Retinal fundus photograph.
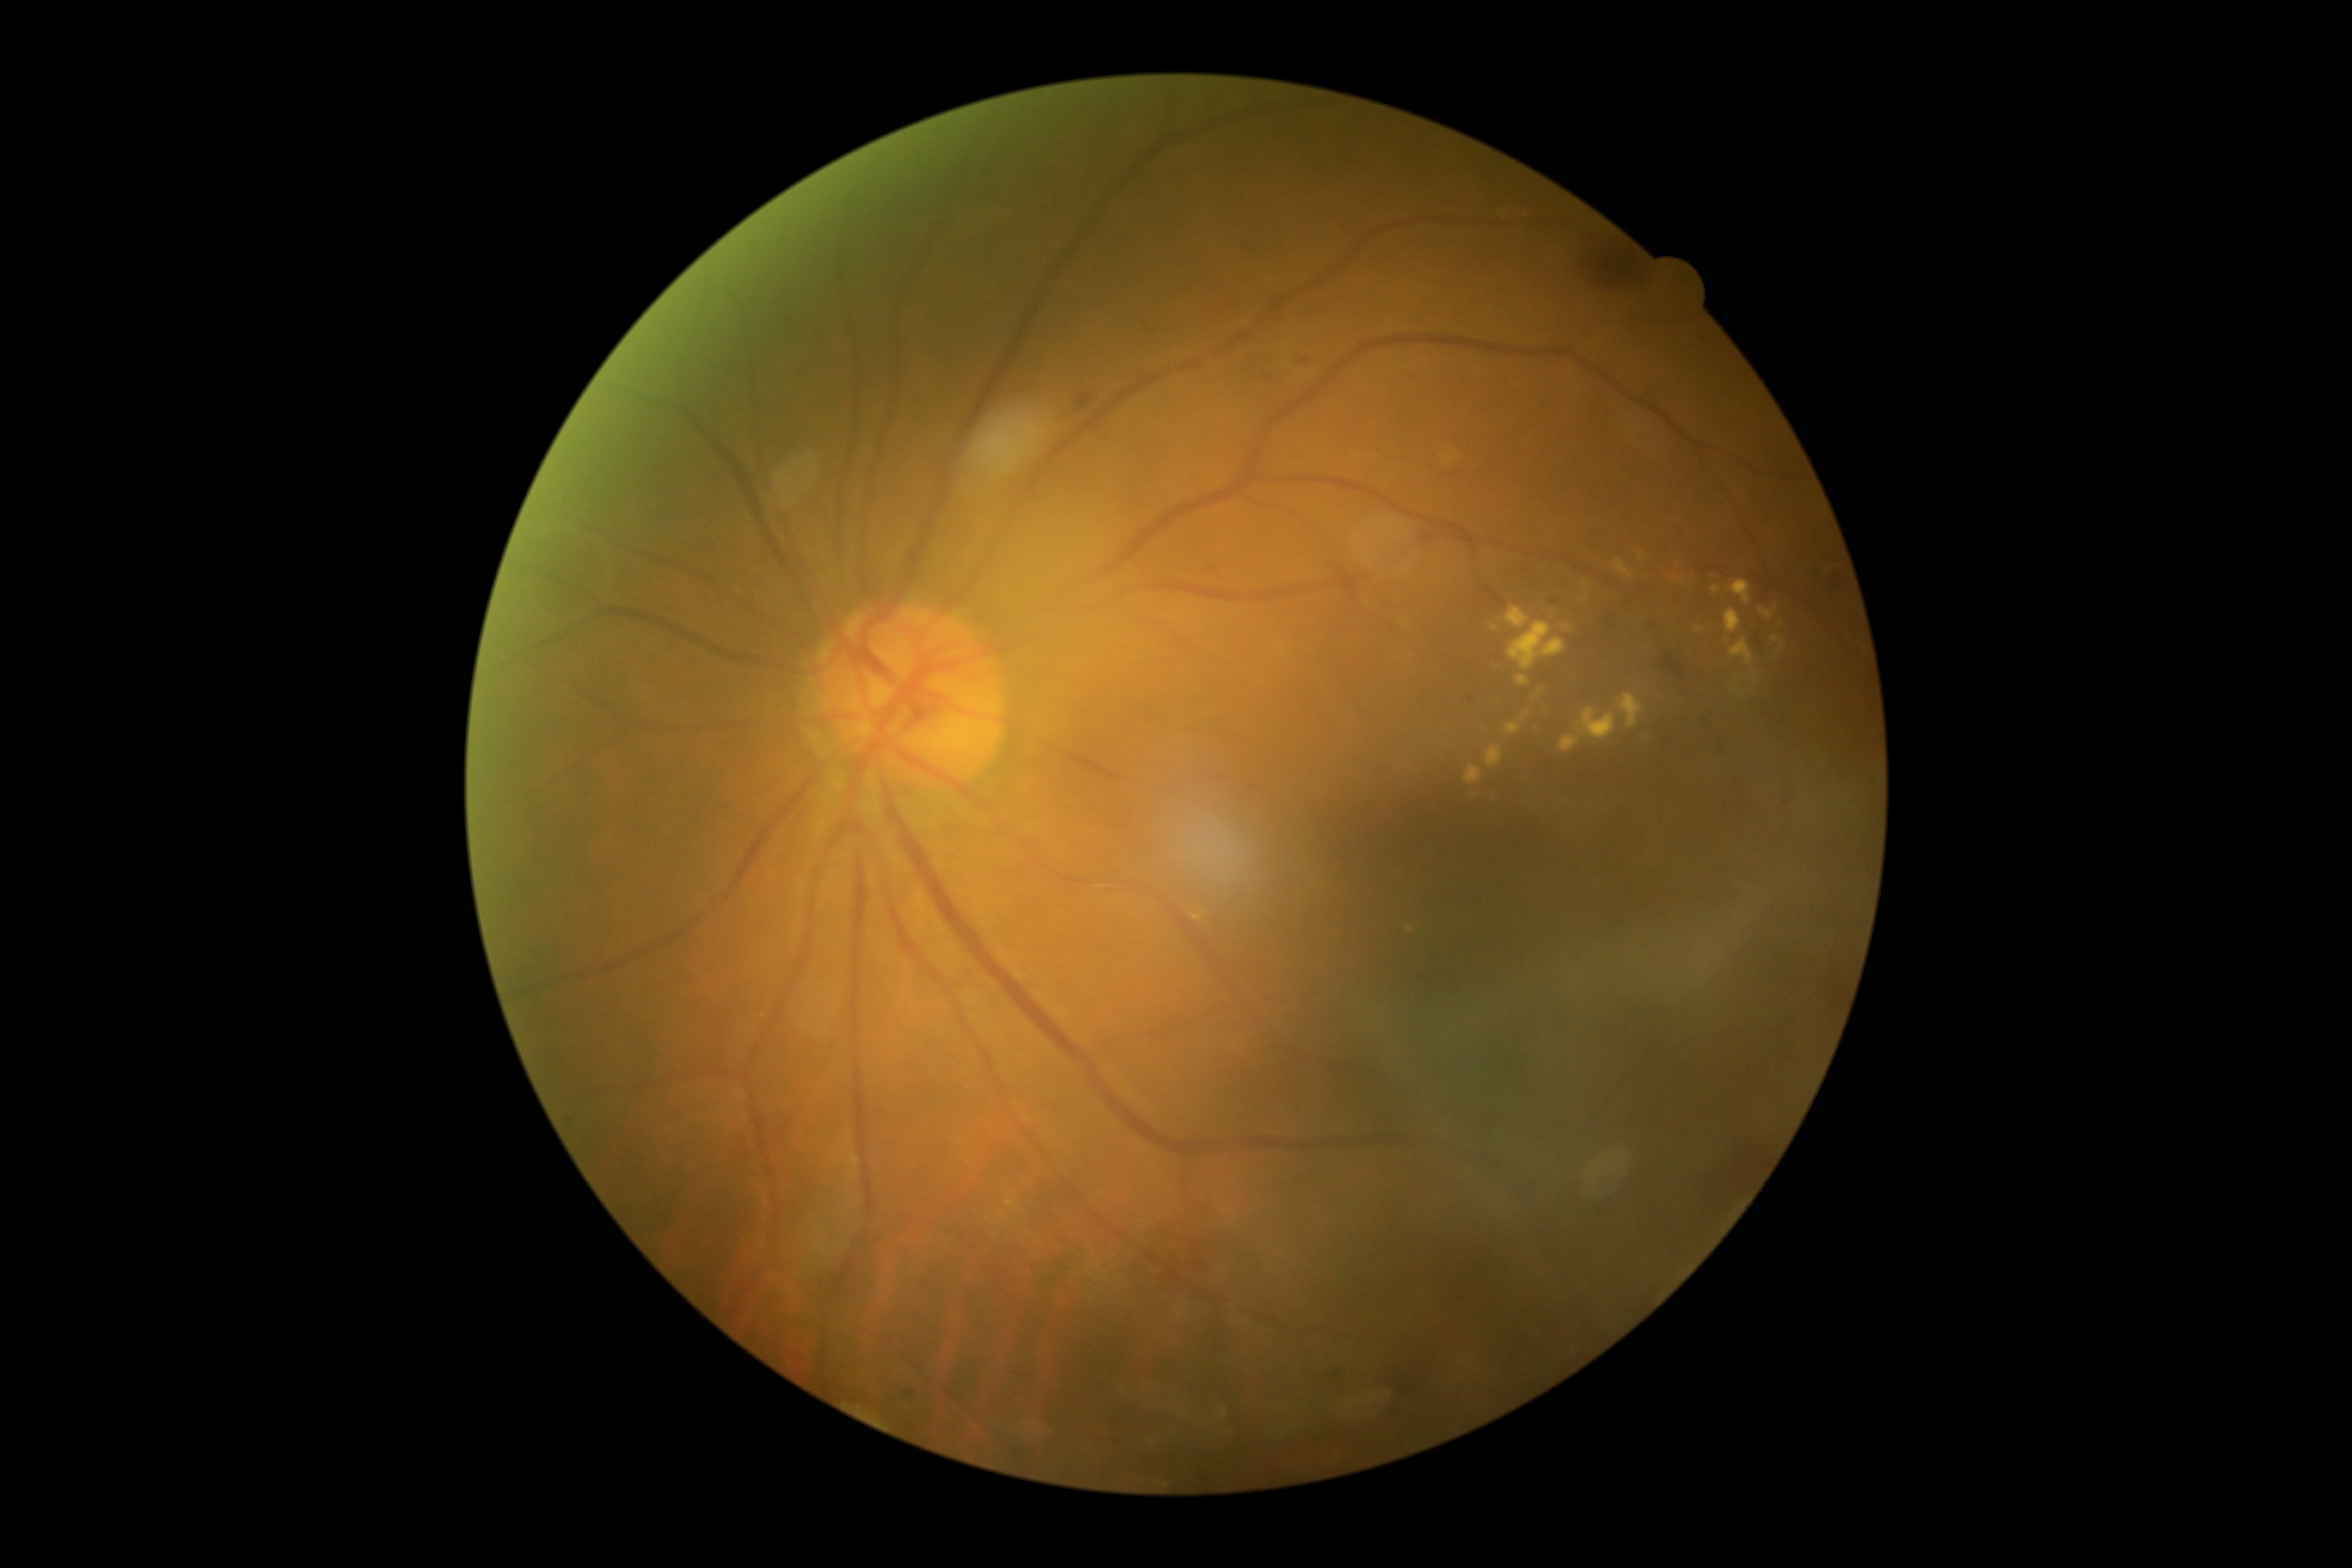

Diabetic retinopathy grade is 2/4
A subset of detected lesions:
- hard exudates (subset): 1574:709:1617:742 | 1712:587:1720:596 | 1760:609:1777:620 | 1516:677:1529:685 | 1729:639:1755:668 | 1772:637:1785:654 | 1505:608:1531:628 | 1192:916:1203:921 | 1485:745:1502:769 | 1559:735:1579:754
- Smaller hard exudates around (x=1699, y=629) | (x=1567, y=627) | (x=1585, y=584)